Wide-field fundus photograph from neonatal ROP screening: 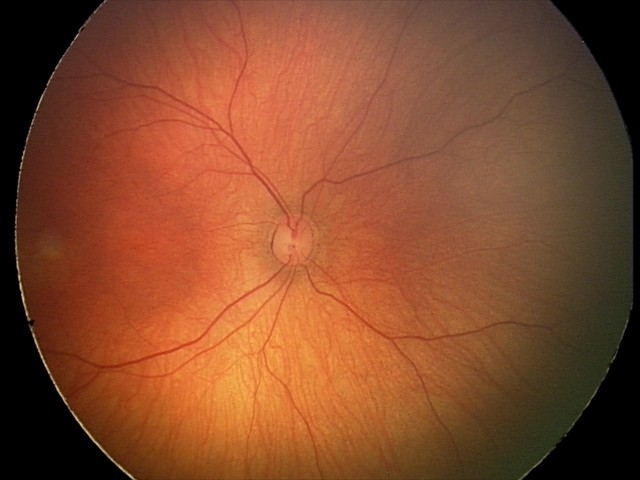
Q: What is the screening diagnosis?
A: normal fundus examination